Fundus photo:
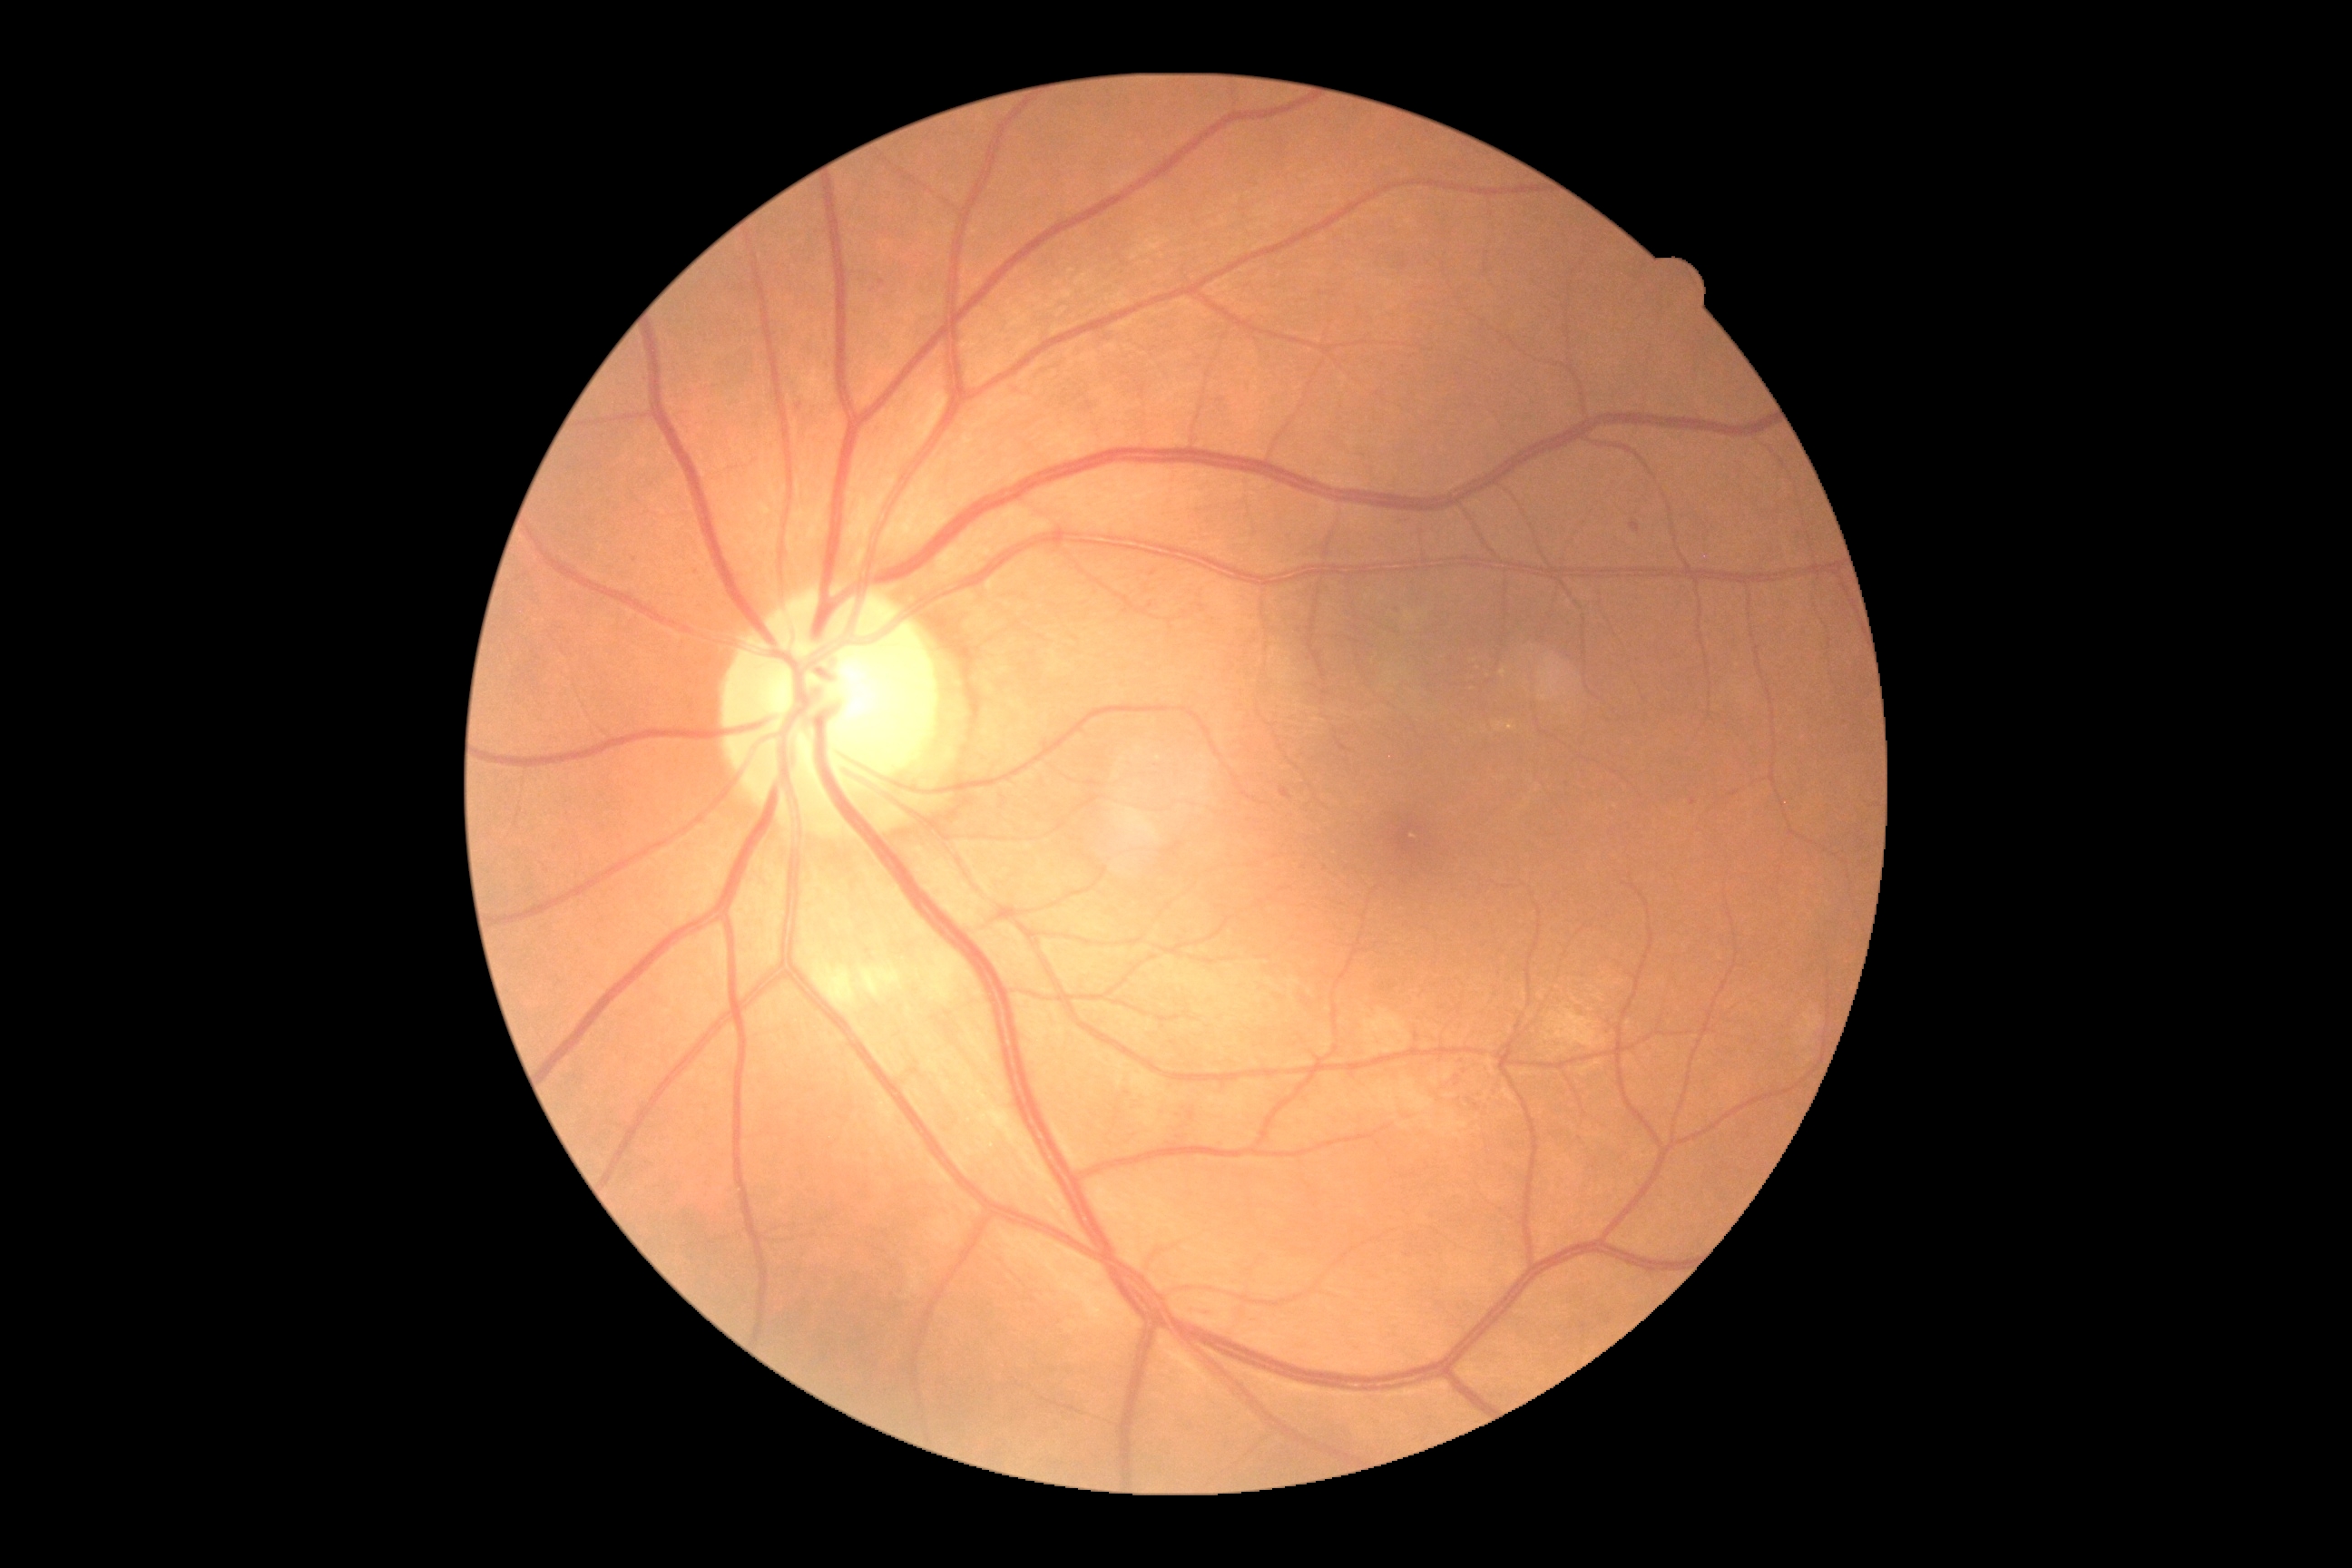
DR grade: moderate non-proliferative diabetic retinopathy (2).